Intraocular pressure 17 mmHg · man:
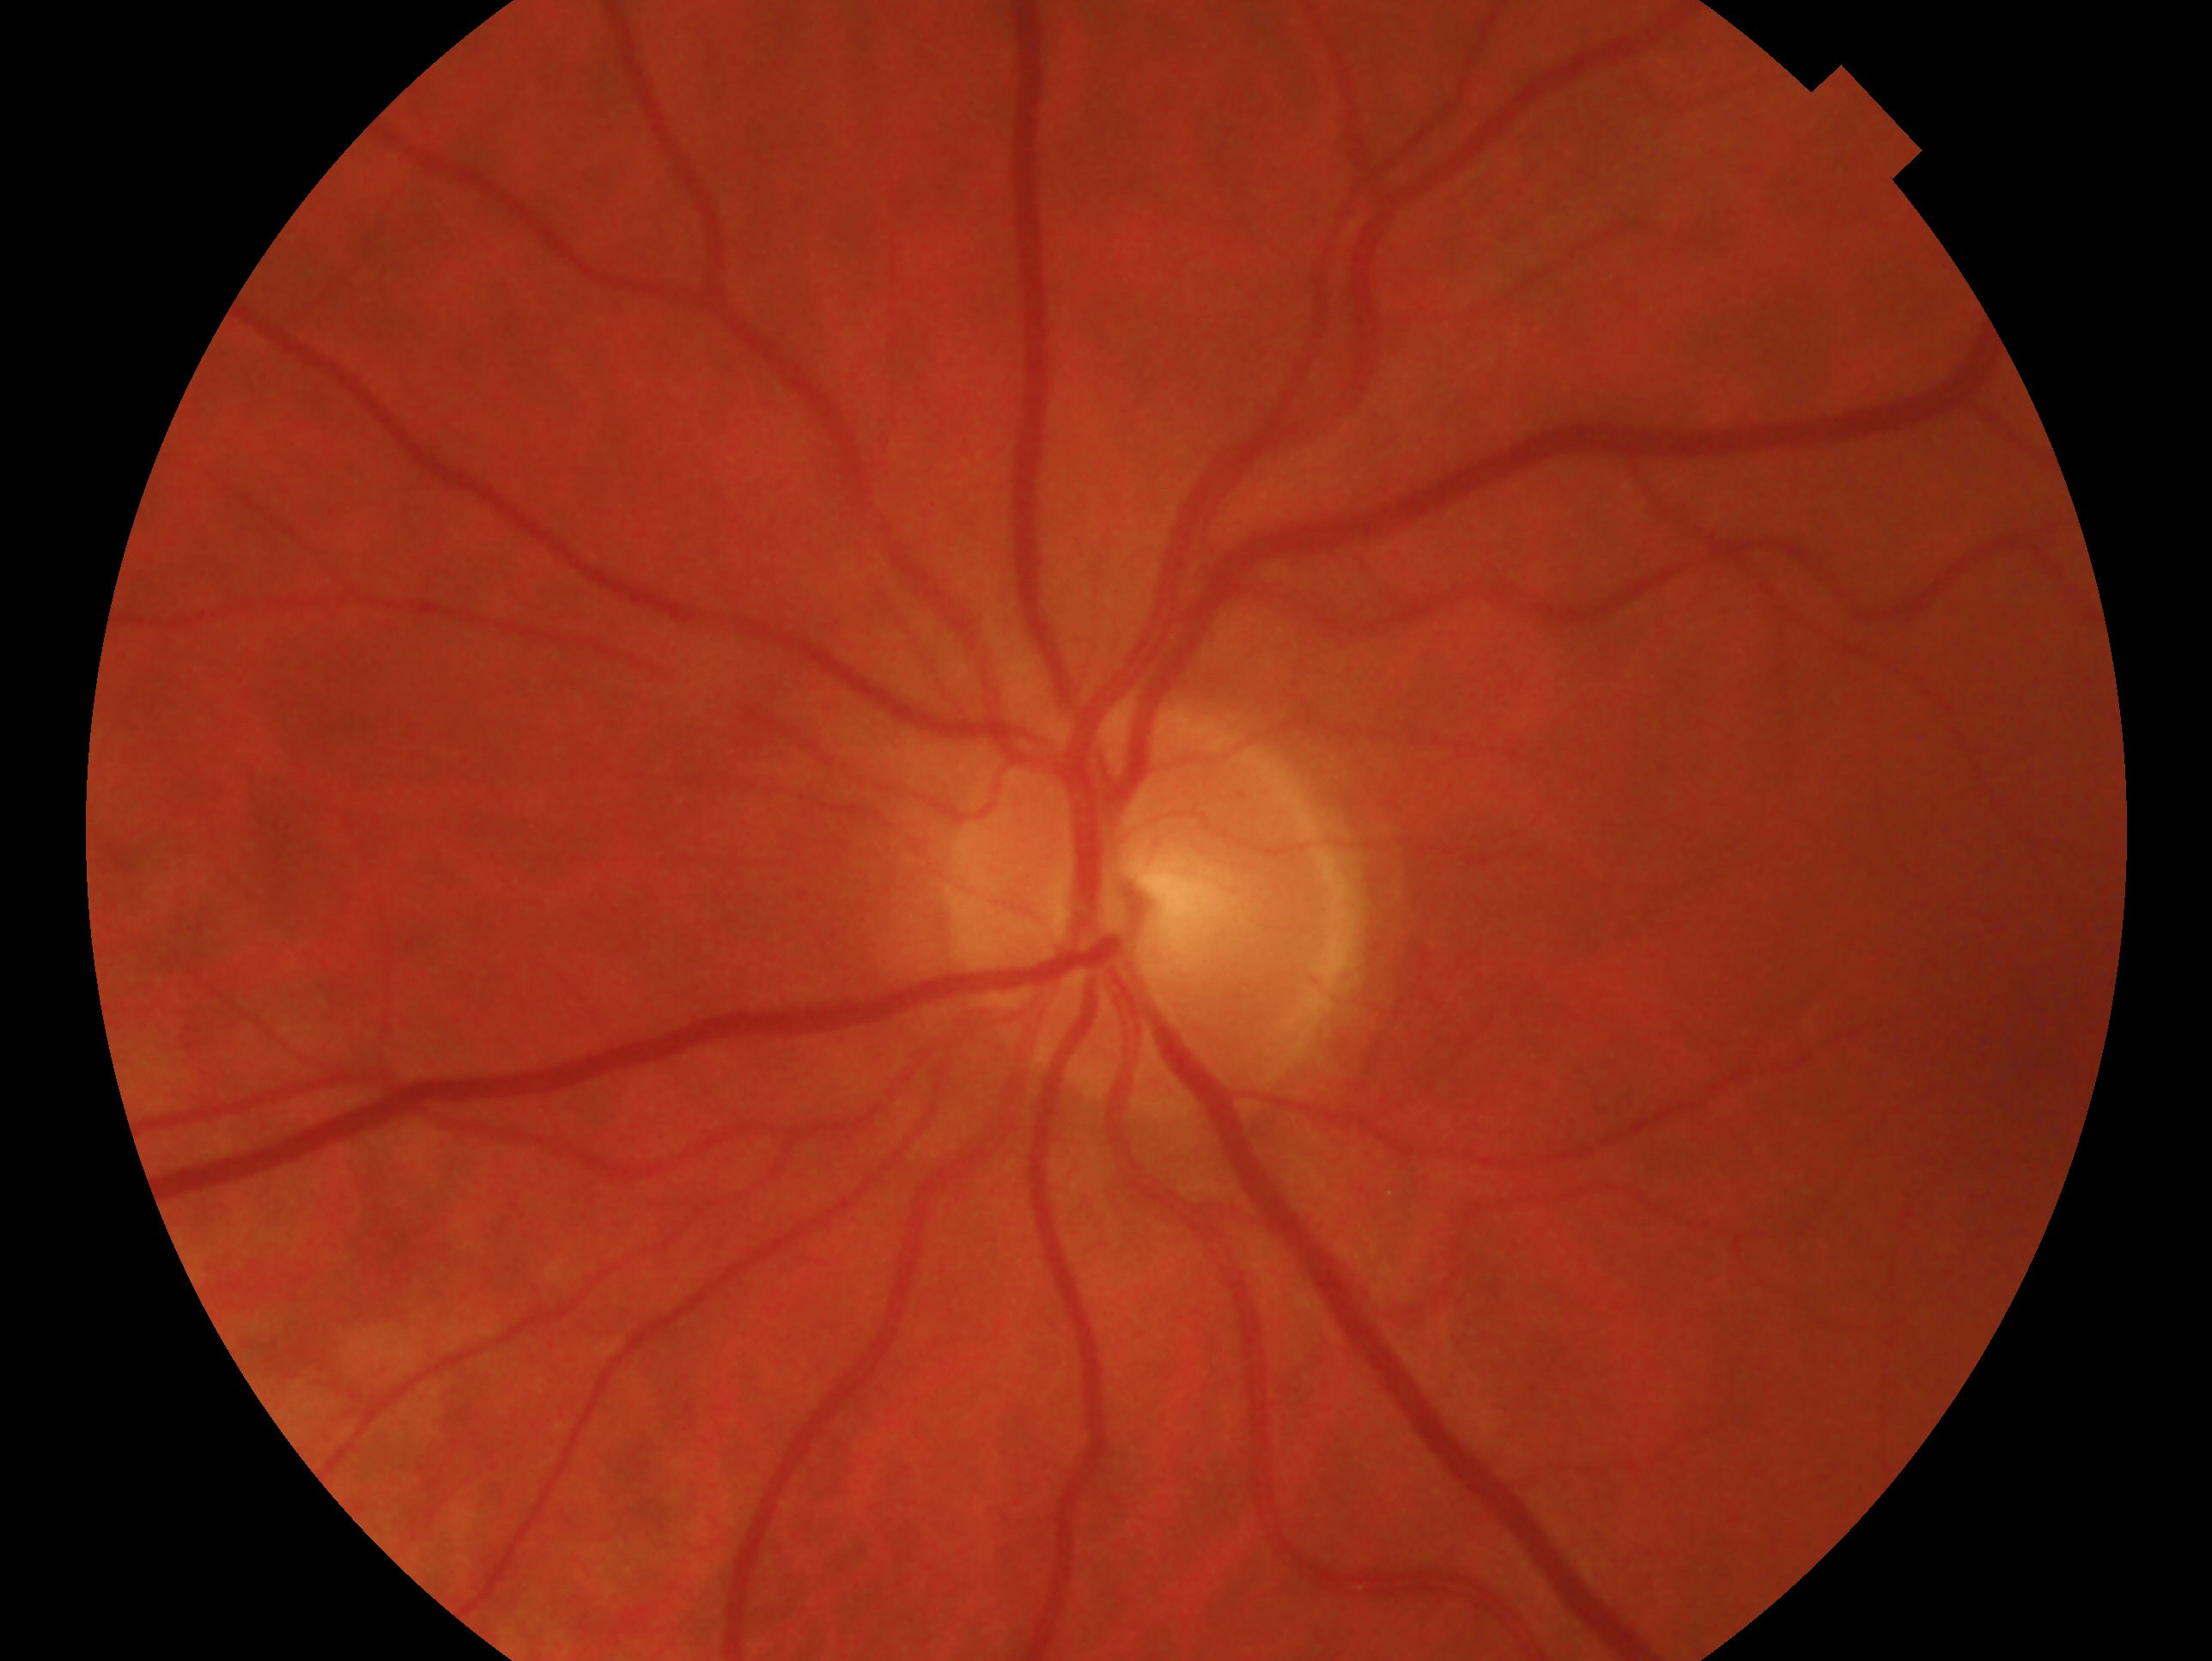 The image shows the OS.
Glaucoma status — no evidence of glaucoma.